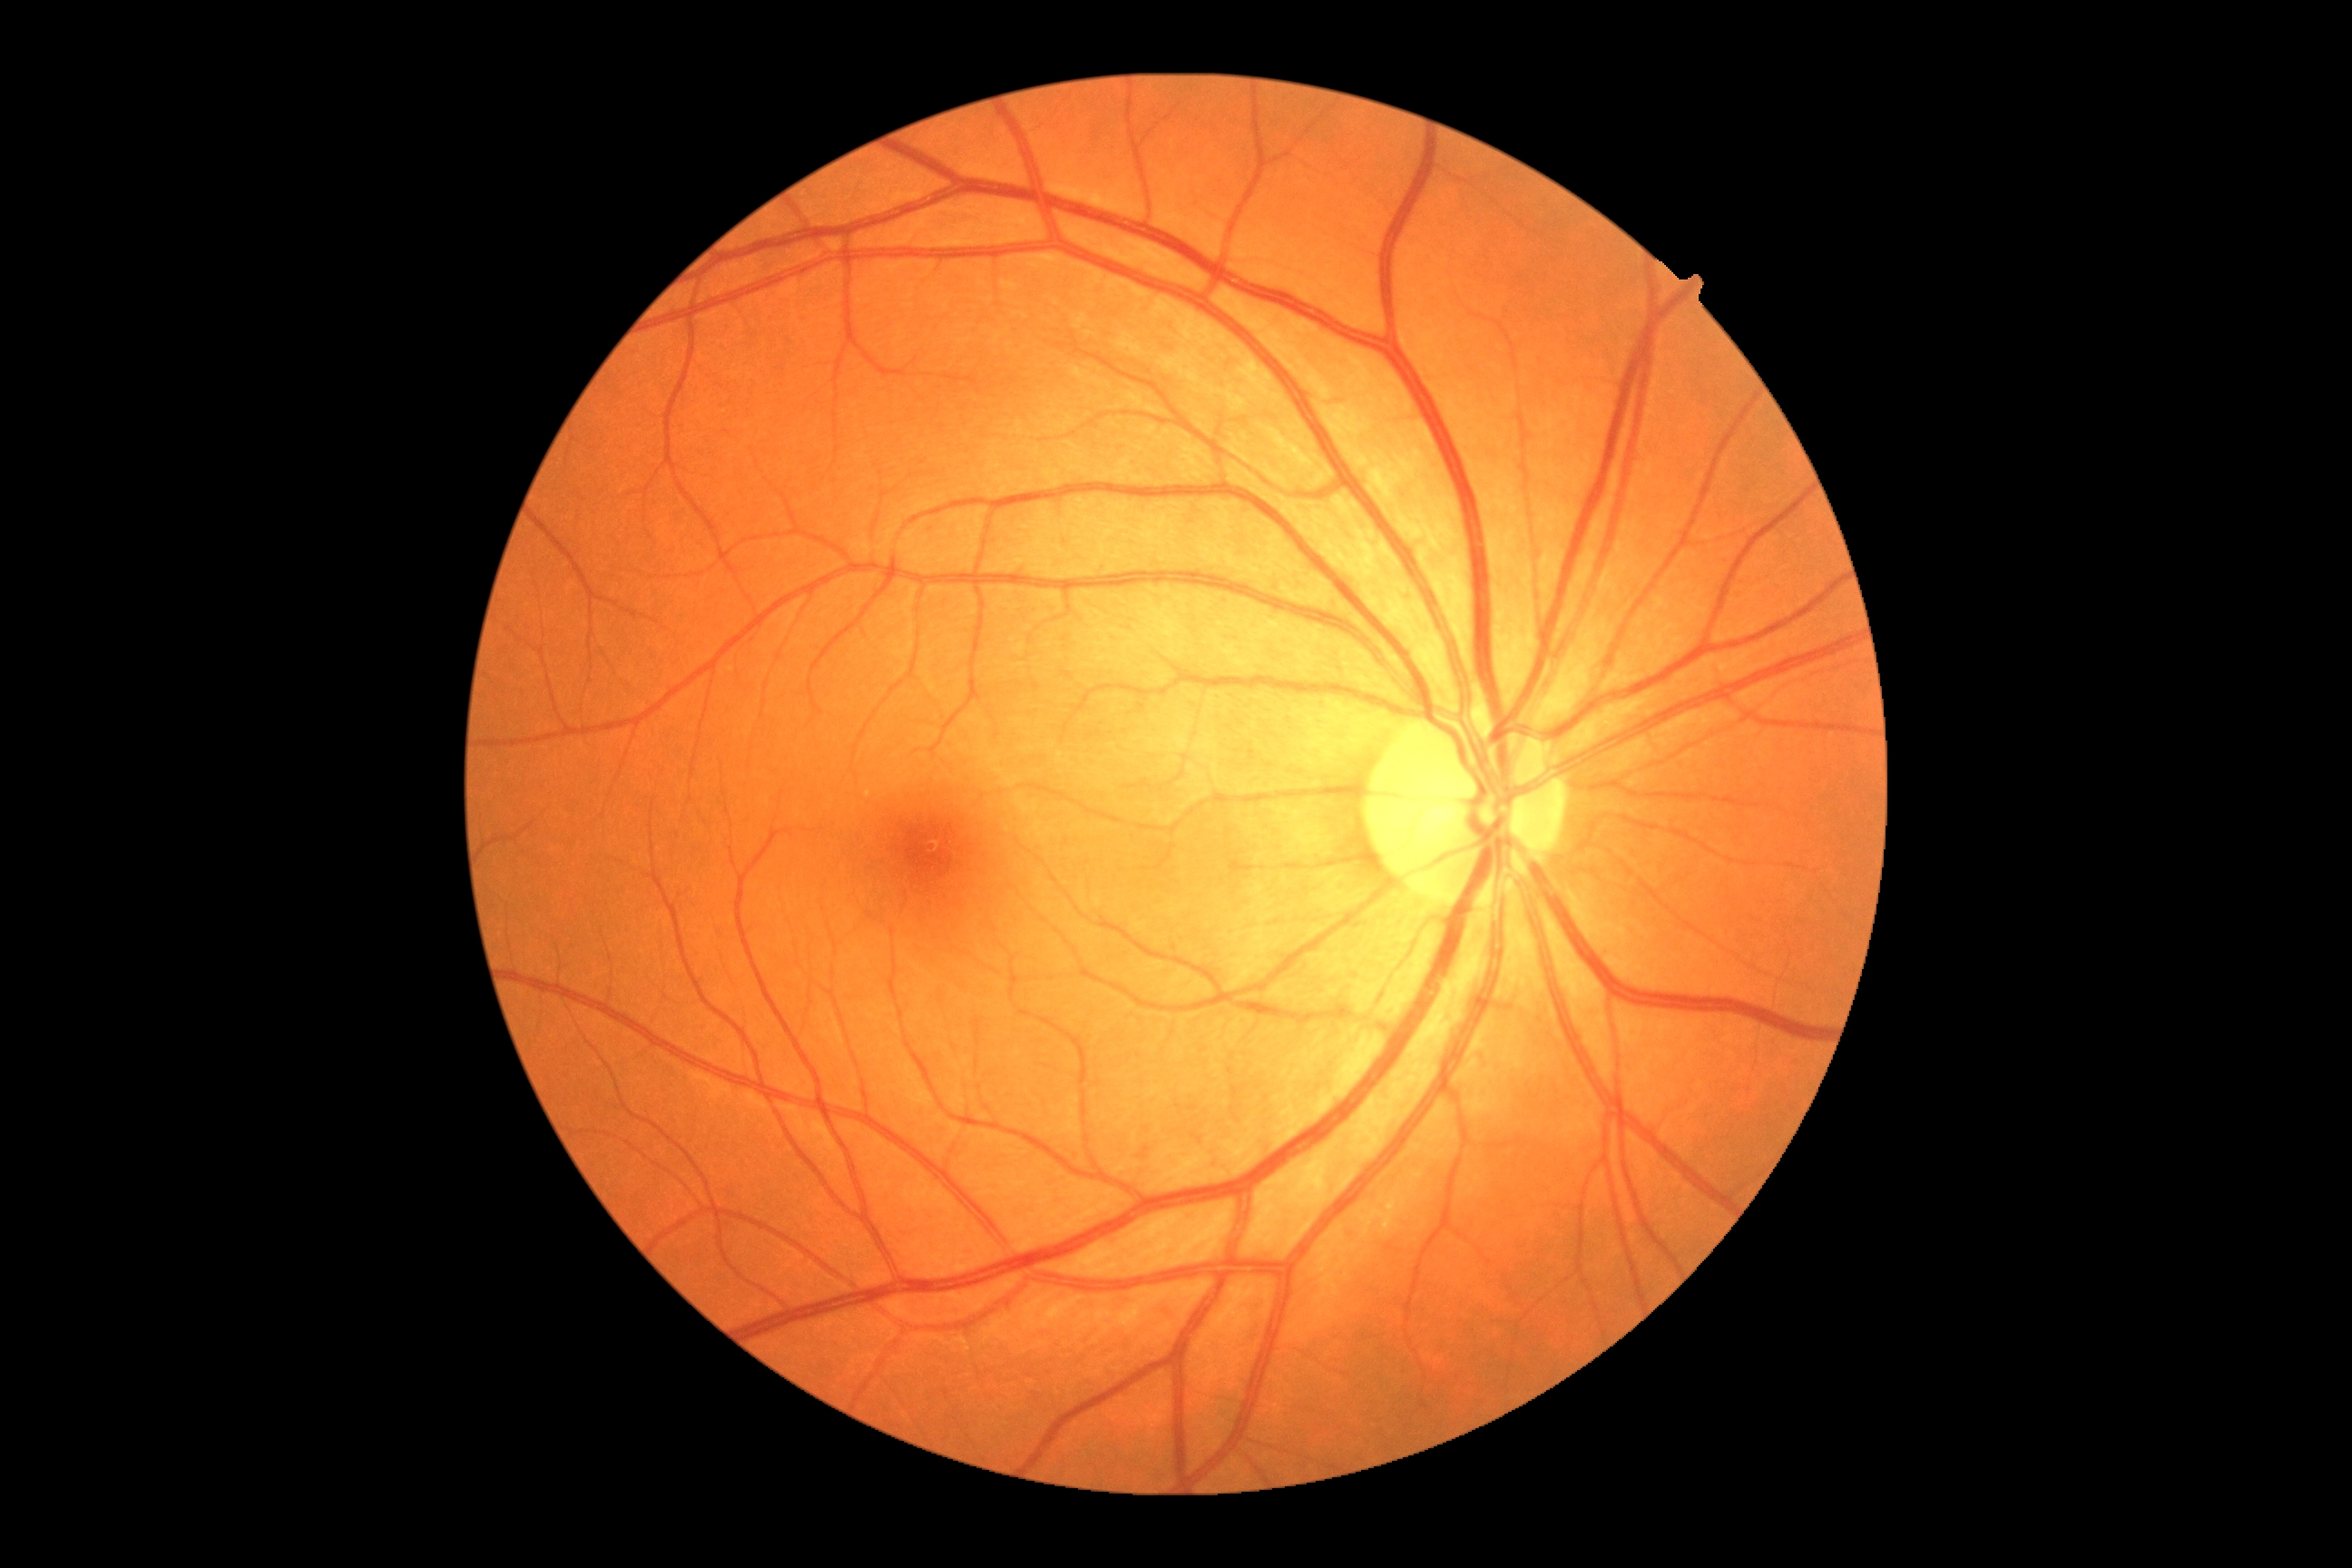

Diabetic retinopathy: no apparent retinopathy (grade 0).
No DR findings.